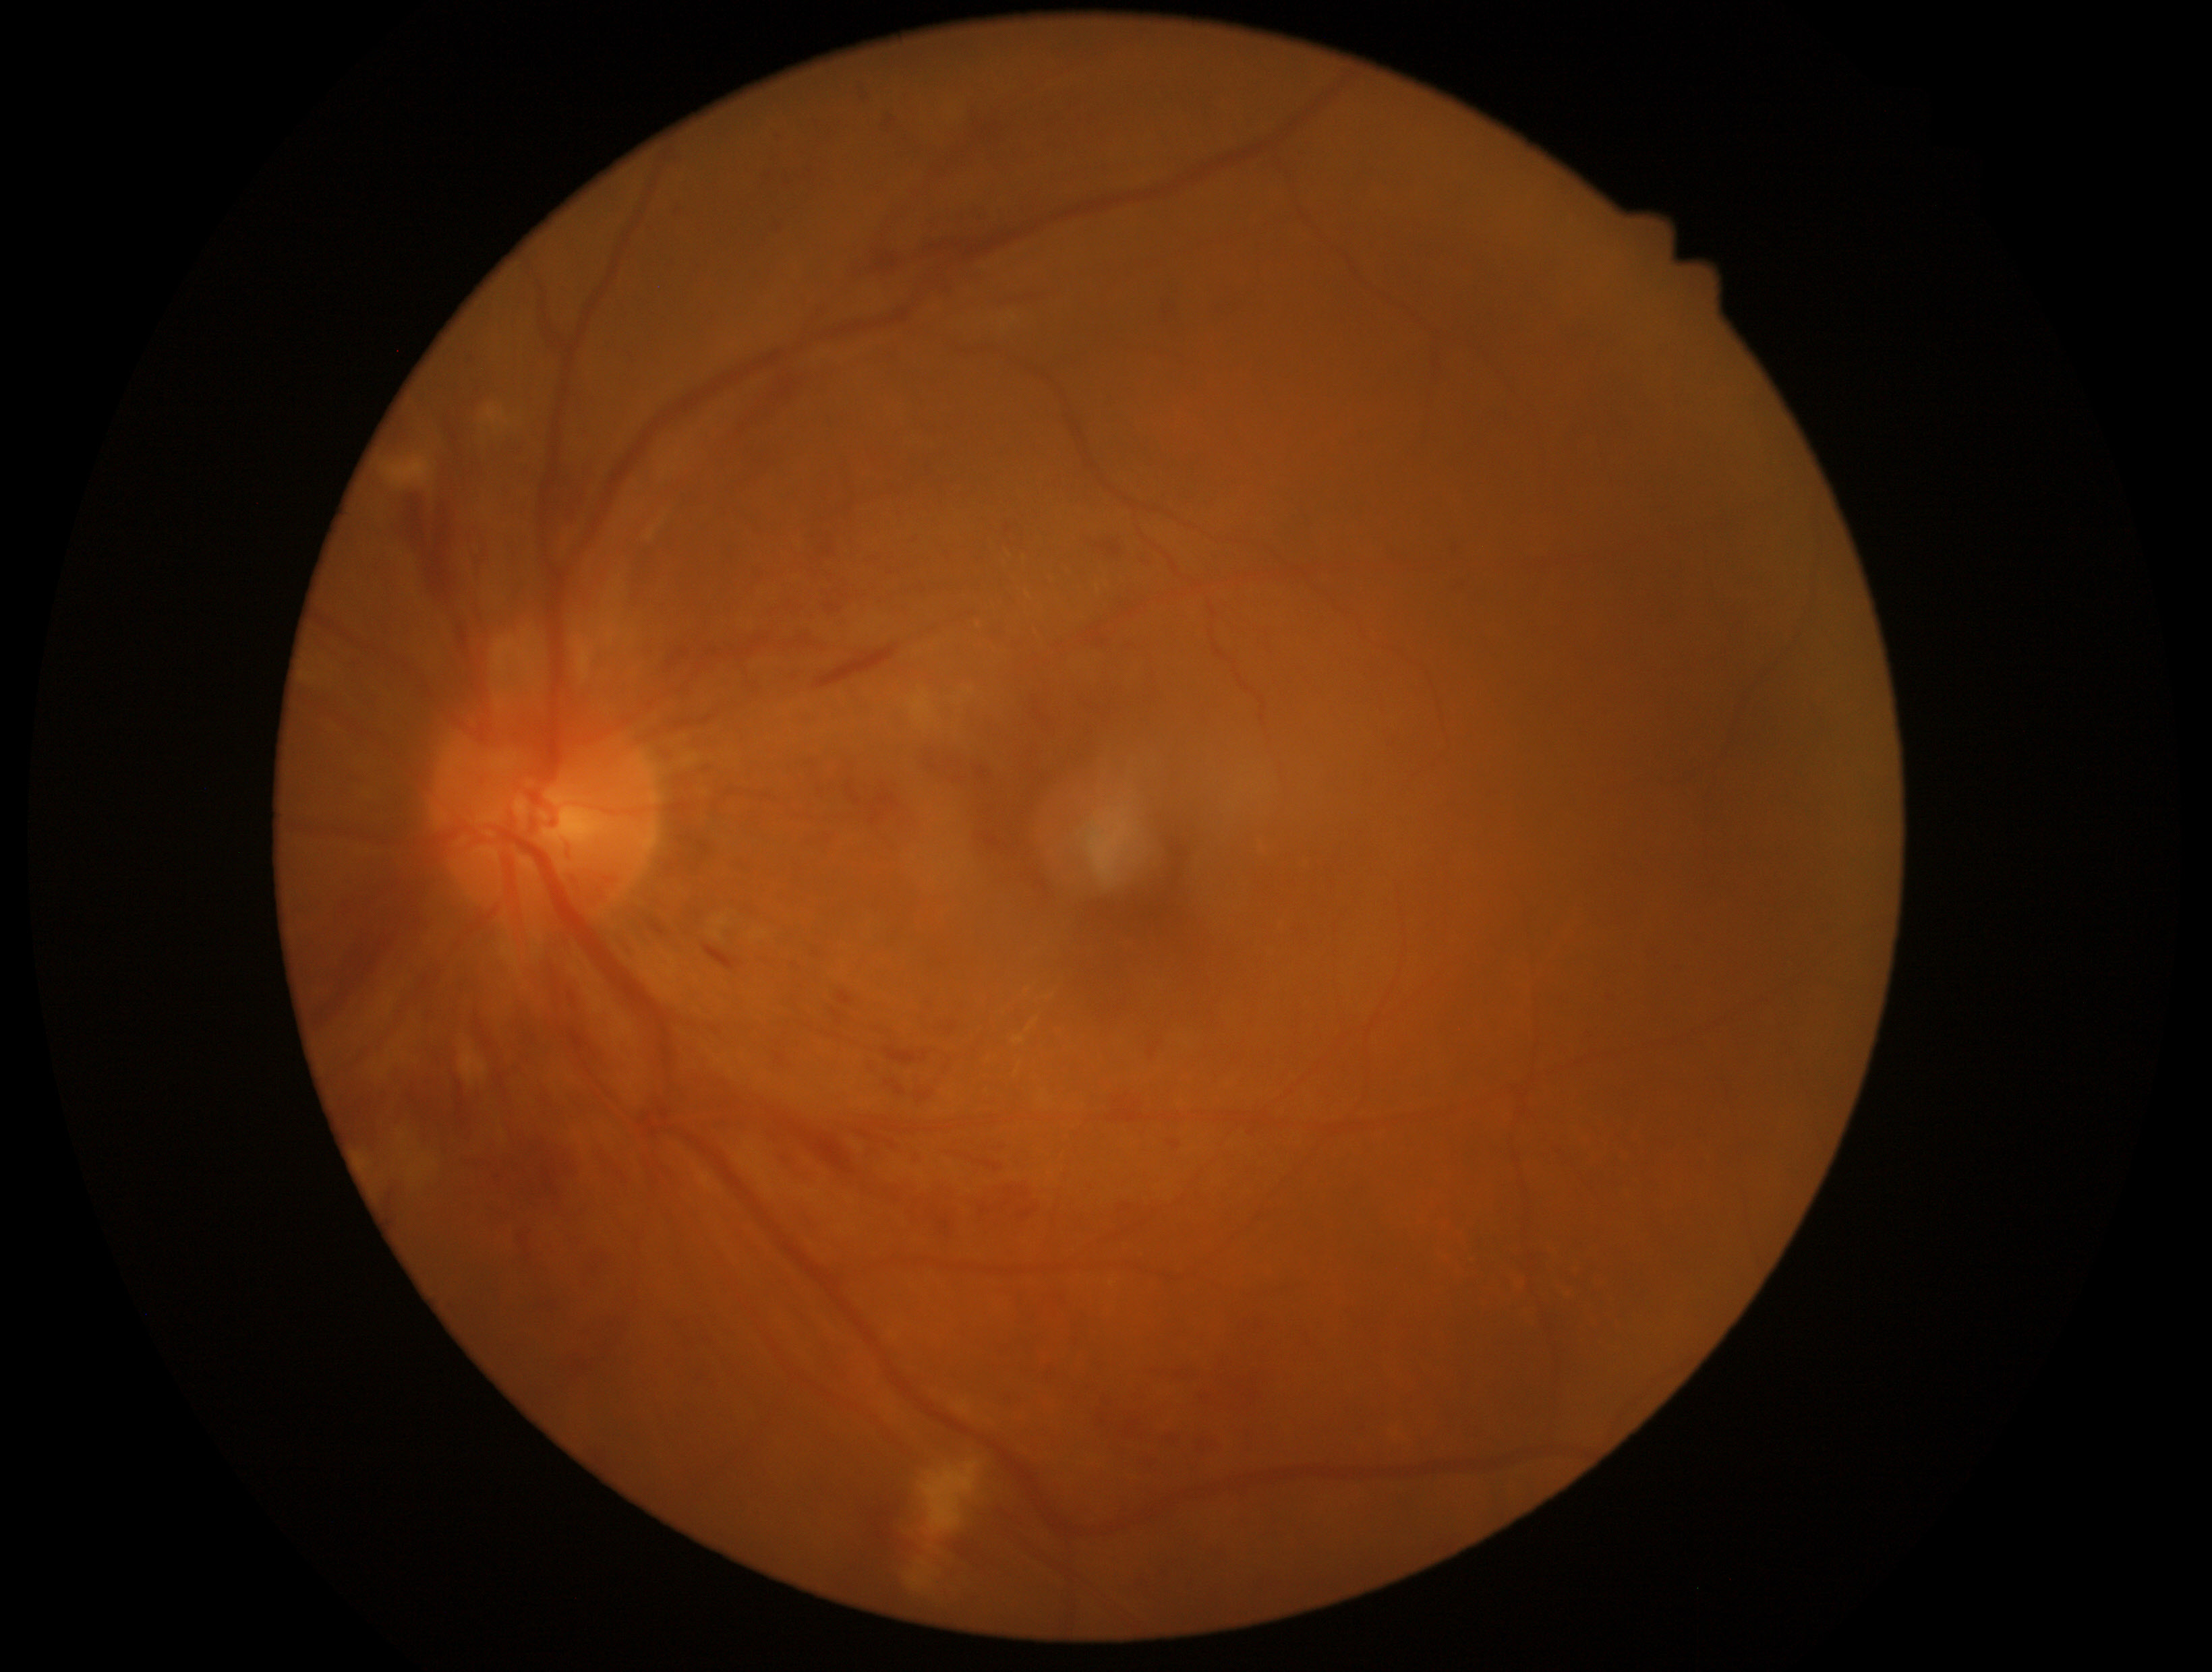   dr_grade: 2